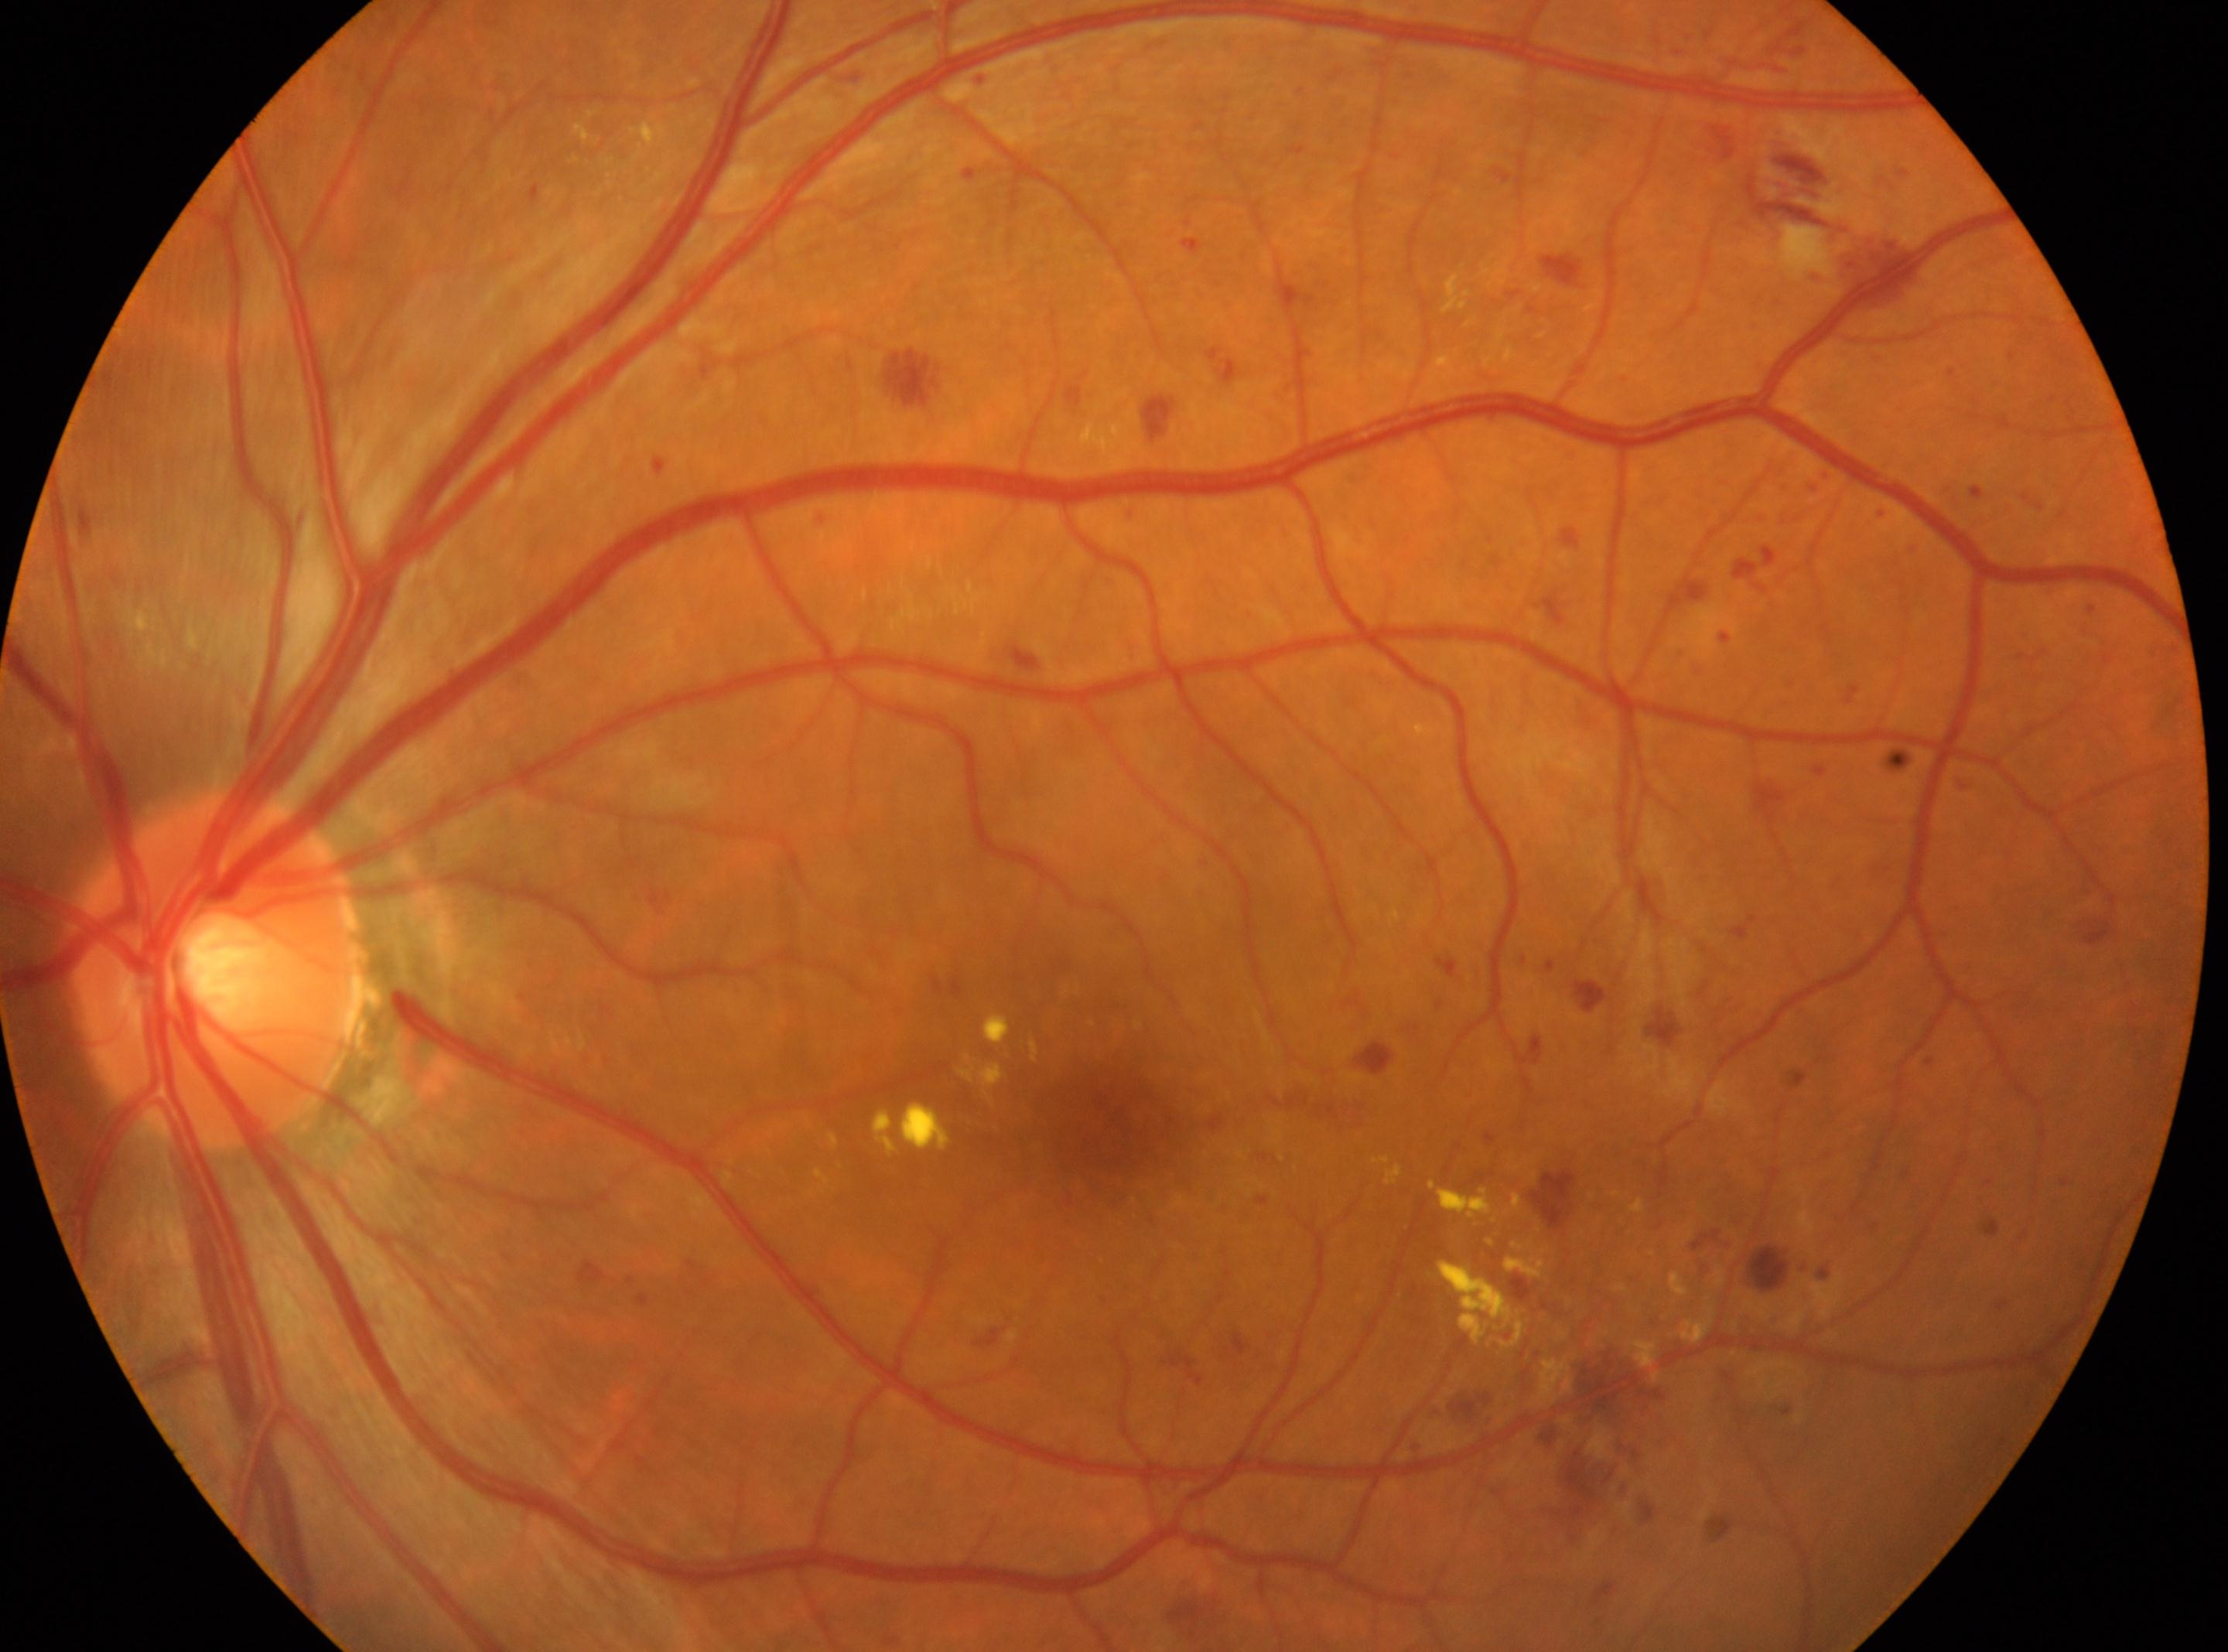

Fovea located at (x=1102, y=1118). The optic disk is at (x=208, y=971). The image shows the left eye. Diabetic retinopathy (DR): grade 3.